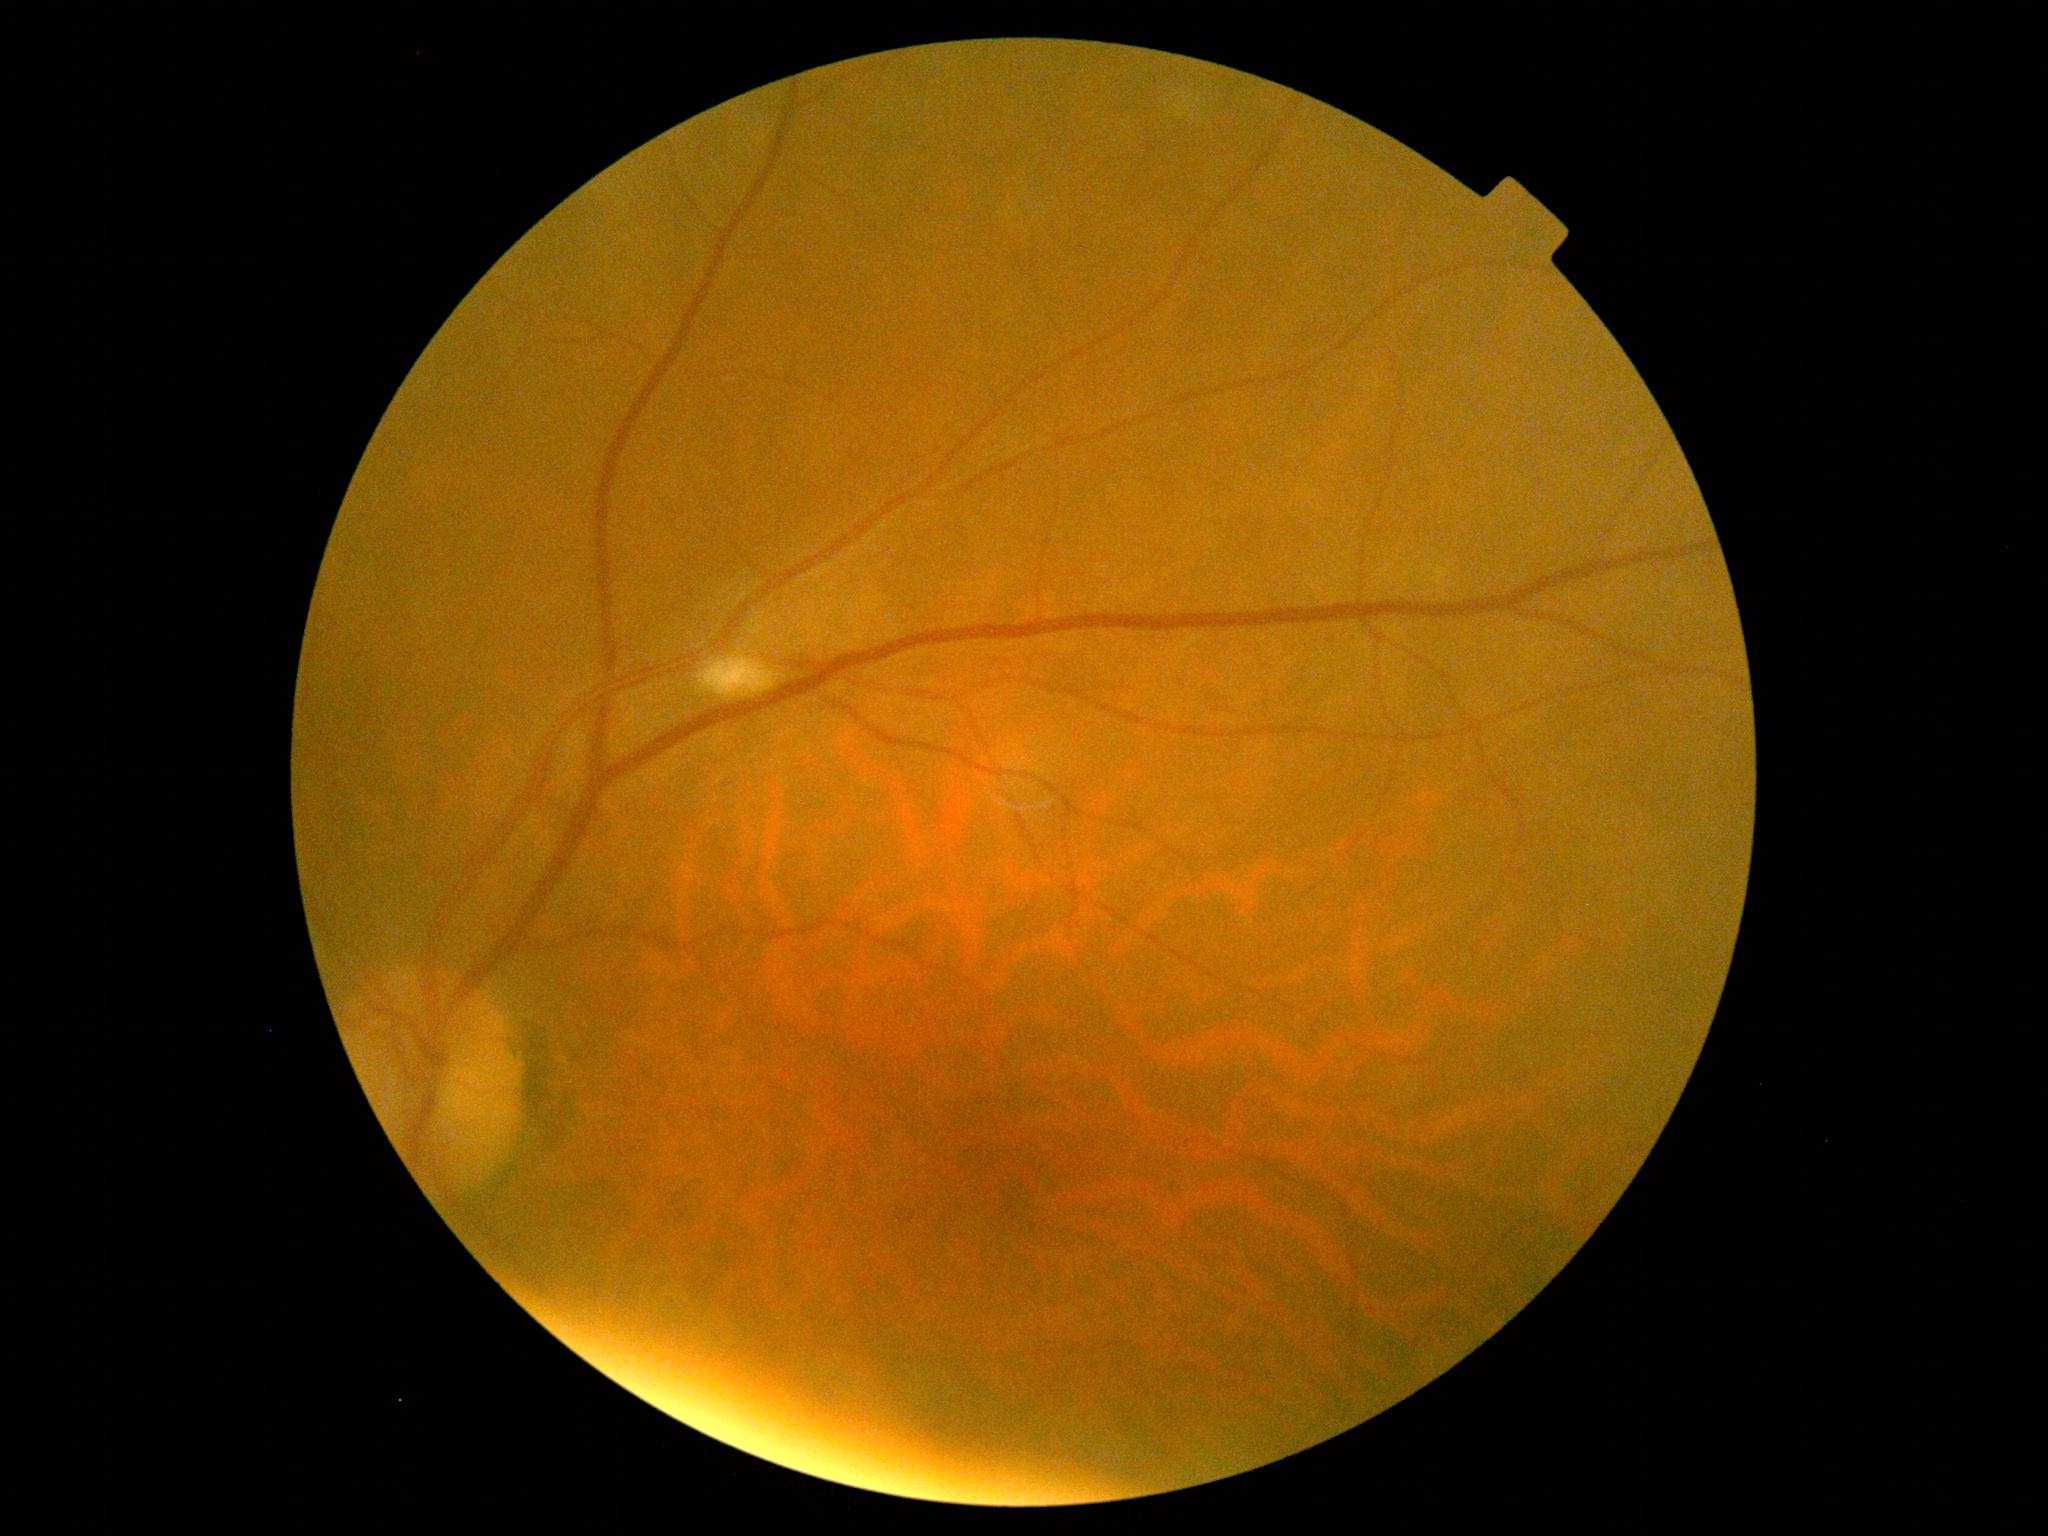

Diabetic retinopathy is 2.